1240 x 1240 pixels; wide-field fundus image from infant ROP screening; captured with the Phoenix ICON (100° field of view):
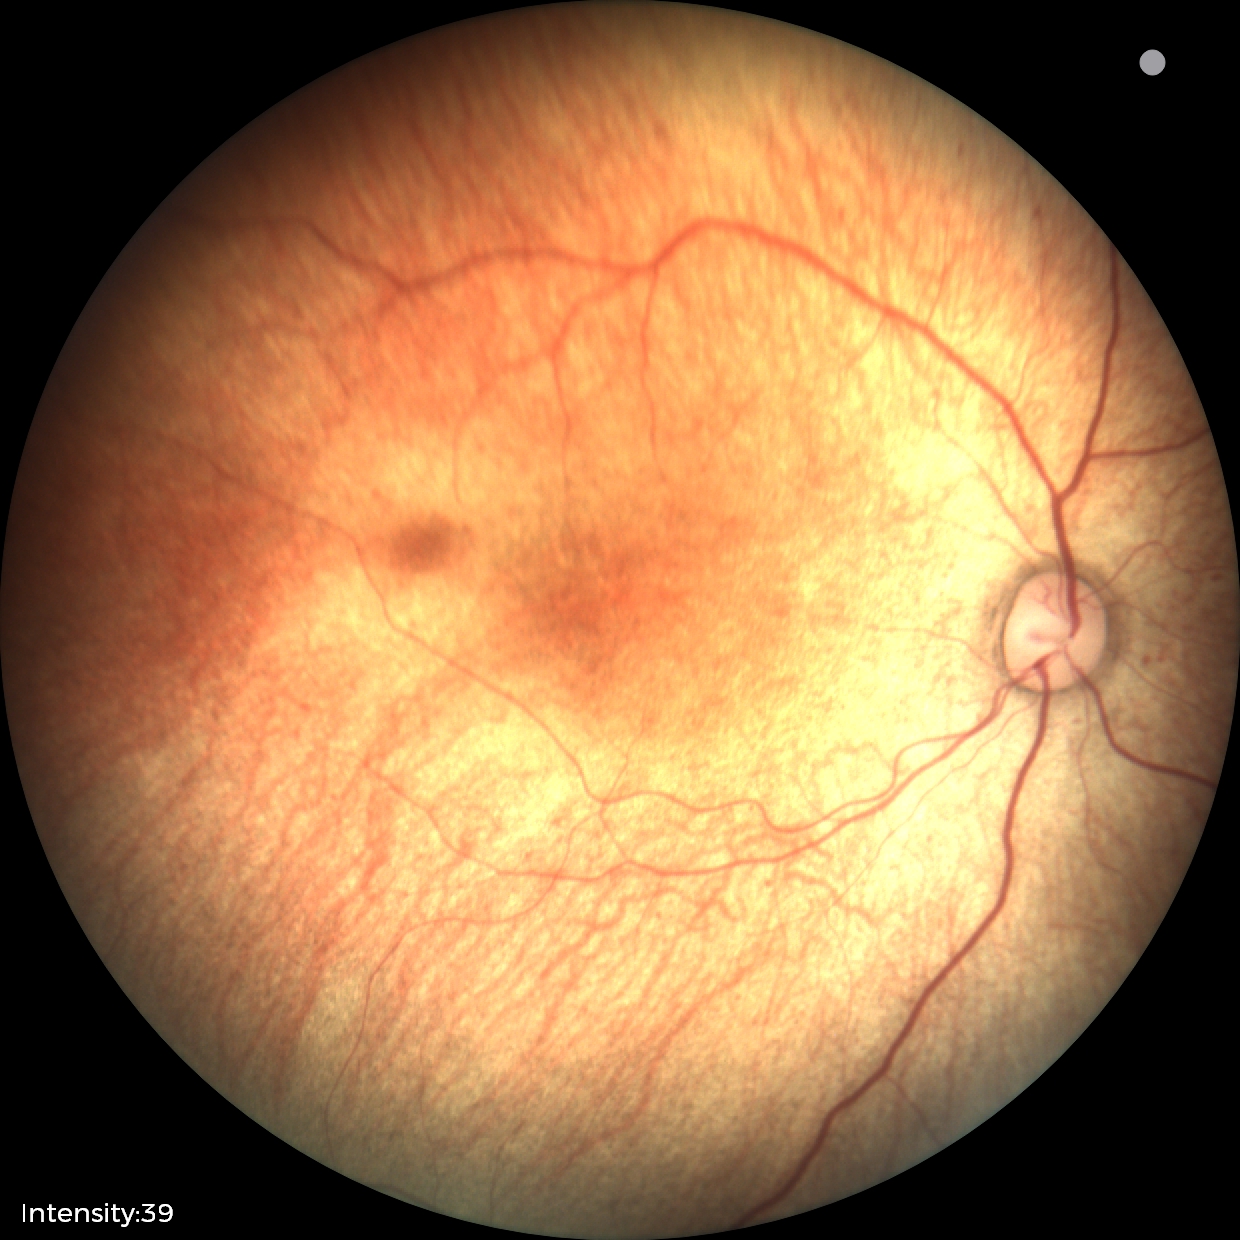
No retinal pathology identified on screening.